Image size 640x480; RetCam wide-field infant fundus image
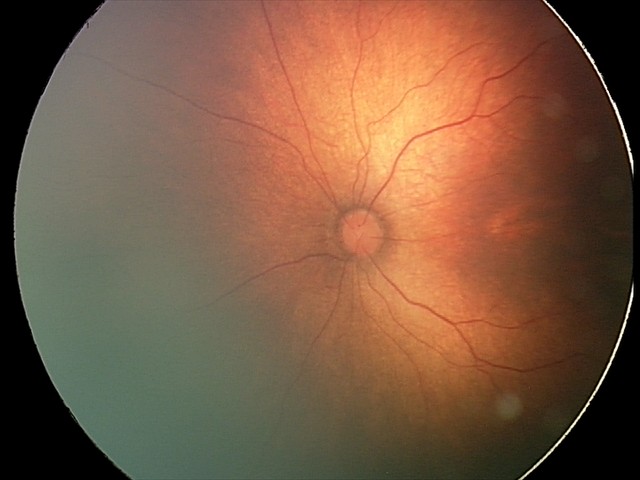 Plus disease: absent; finding: status post retinopathy of prematurity.